2212x1659px:
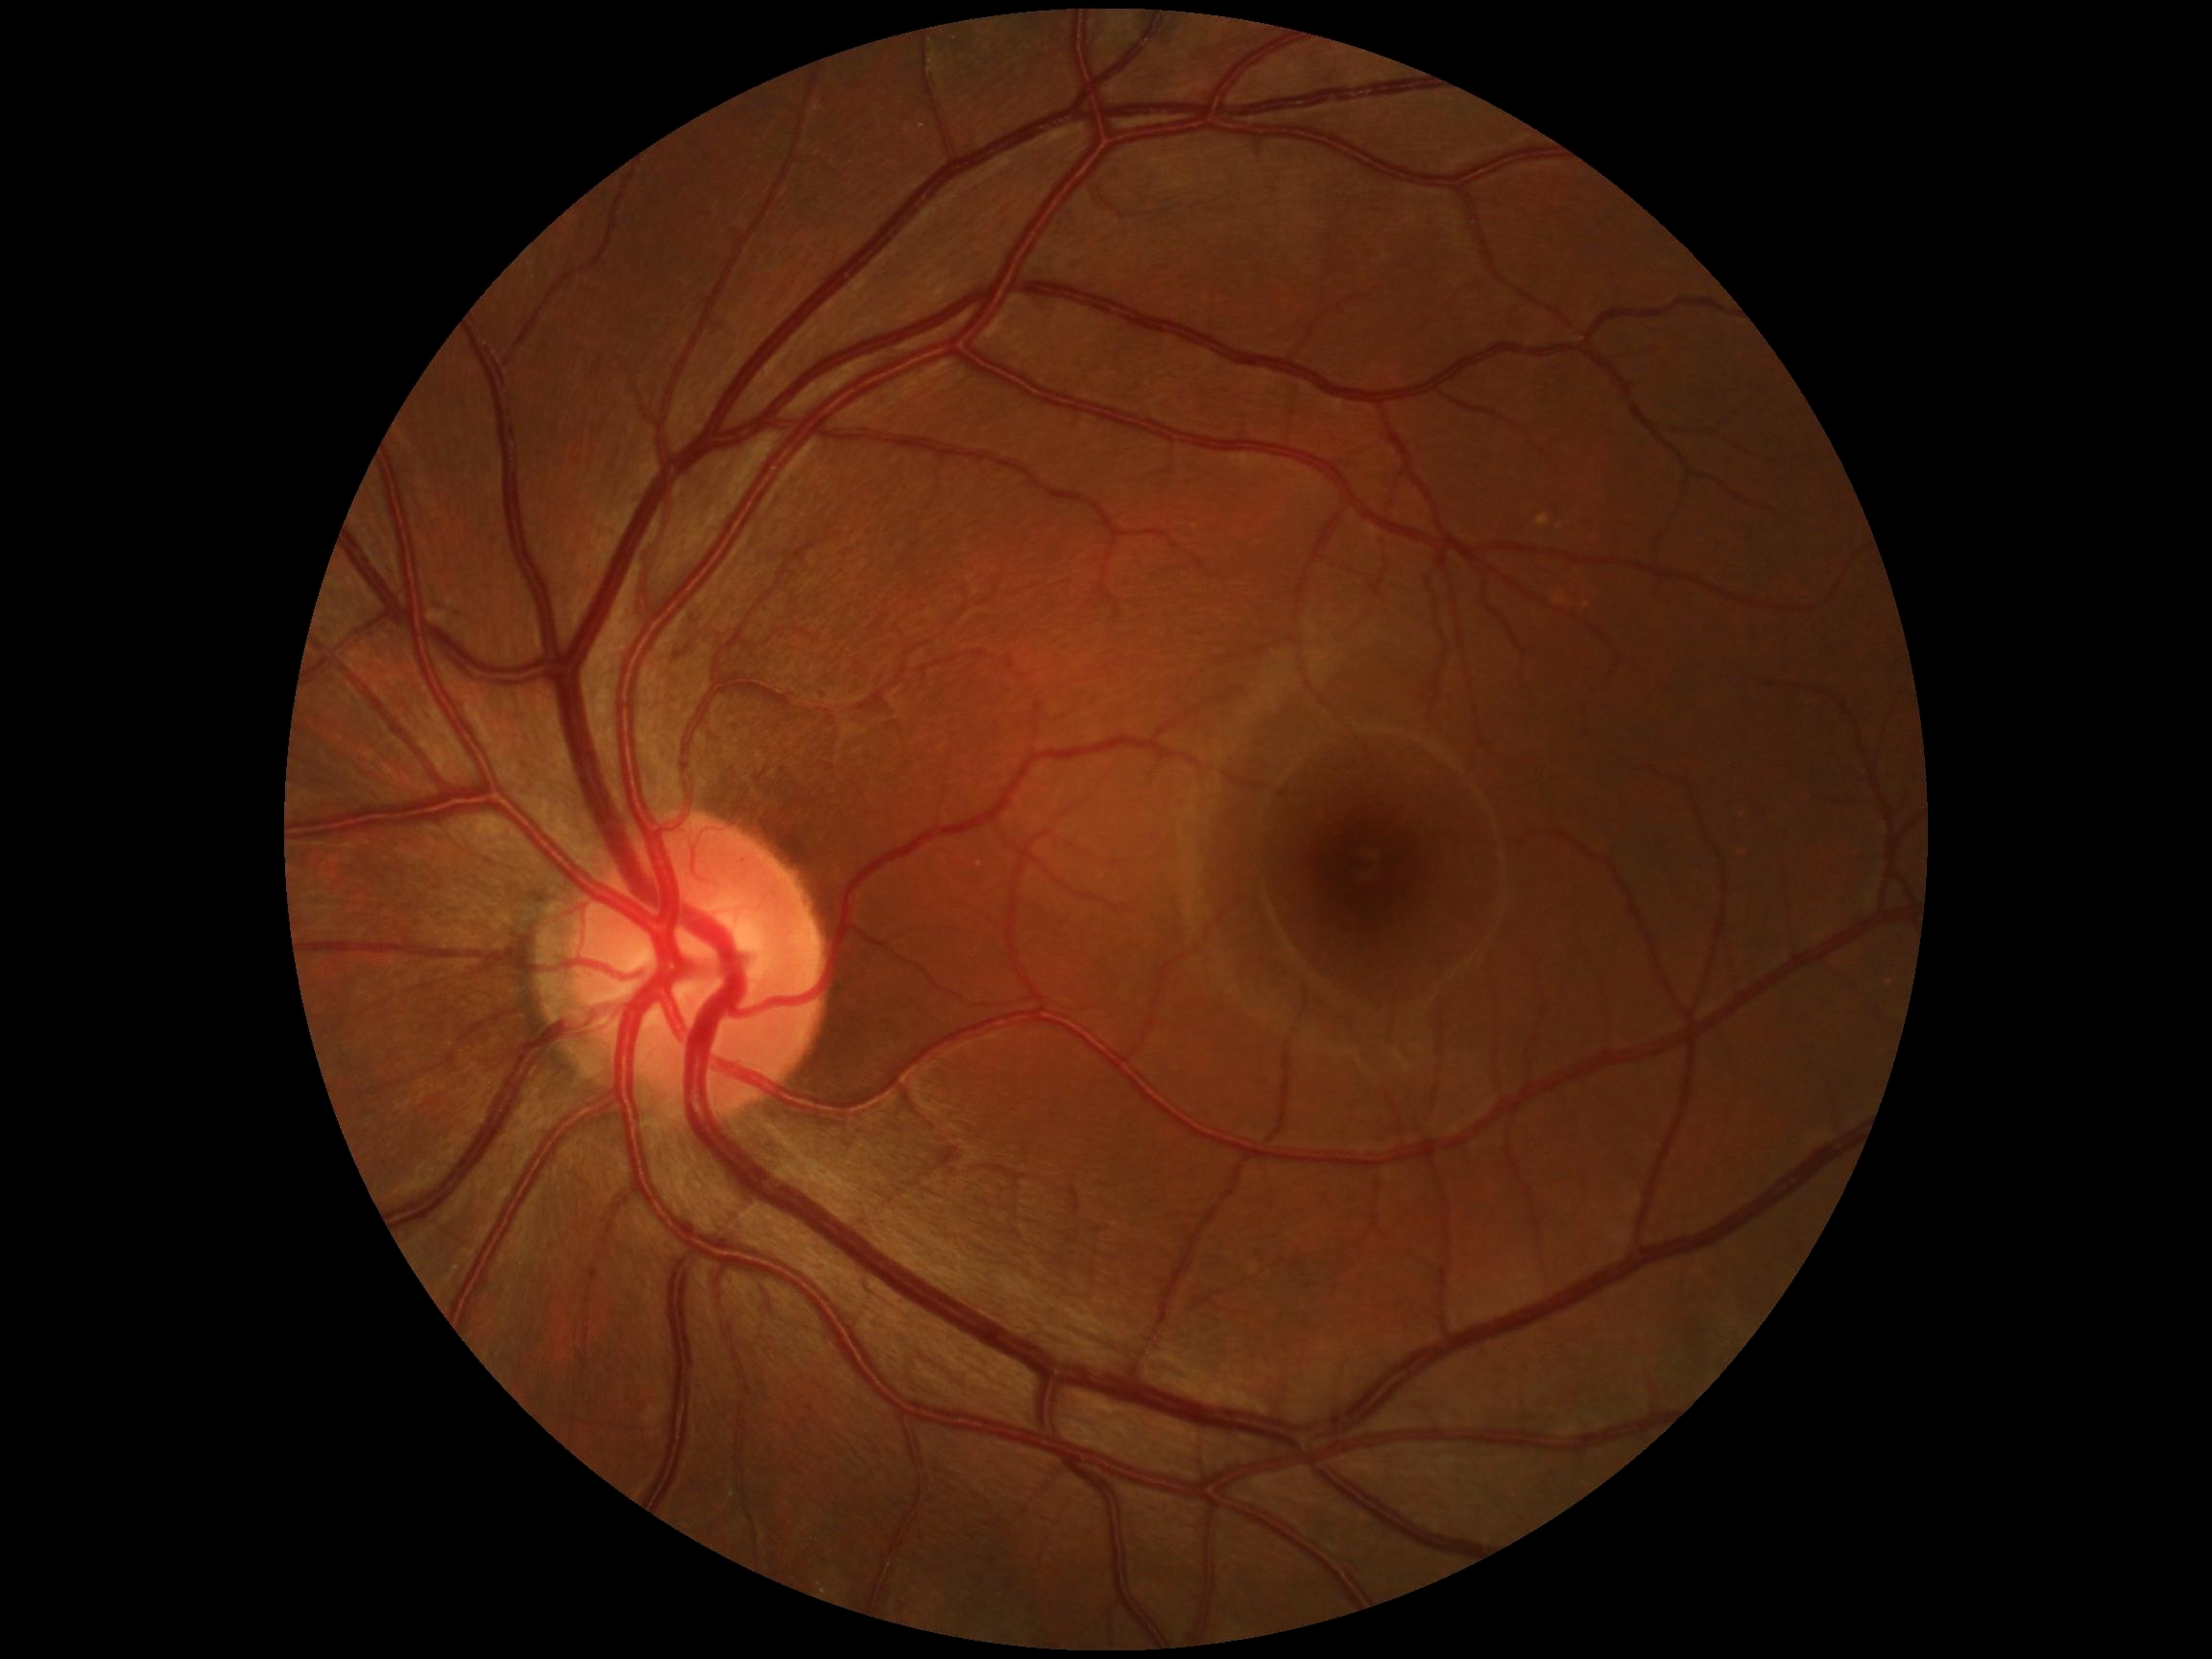
DR impression: negative for DR; diabetic retinopathy severity: grade 0 — no visible signs of diabetic retinopathy.